Nonmydriatic fundus photograph, 45-degree field of view, color fundus image, 848 by 848 pixels — 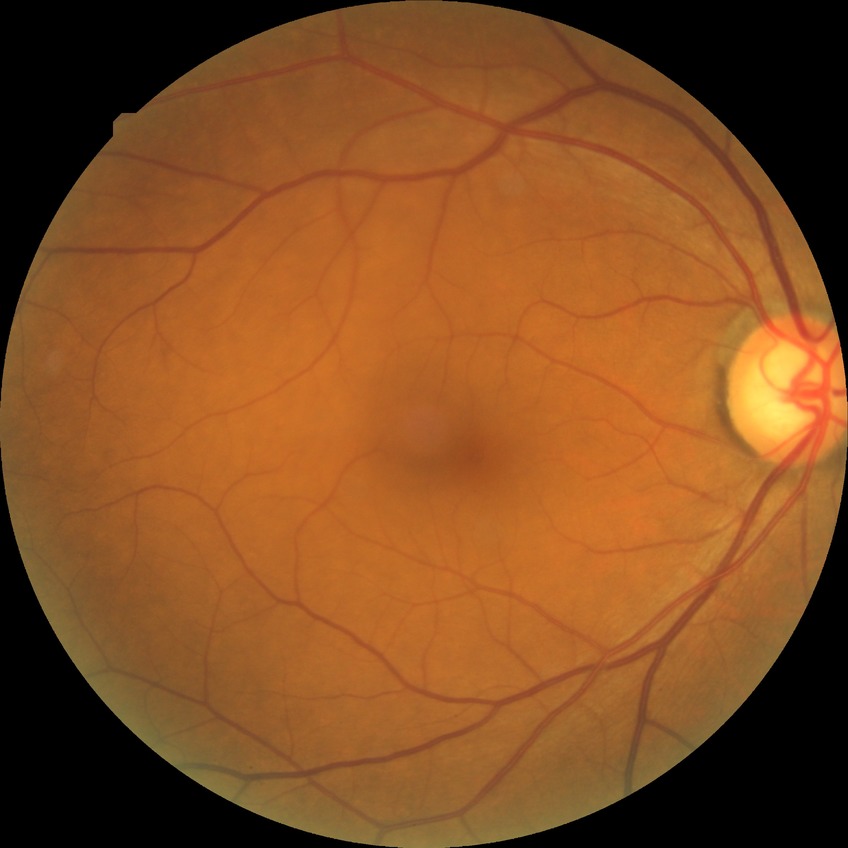

DR impression: no DR findings, DR grade: NDR.